Fundus photo, FOV: 45 degrees — 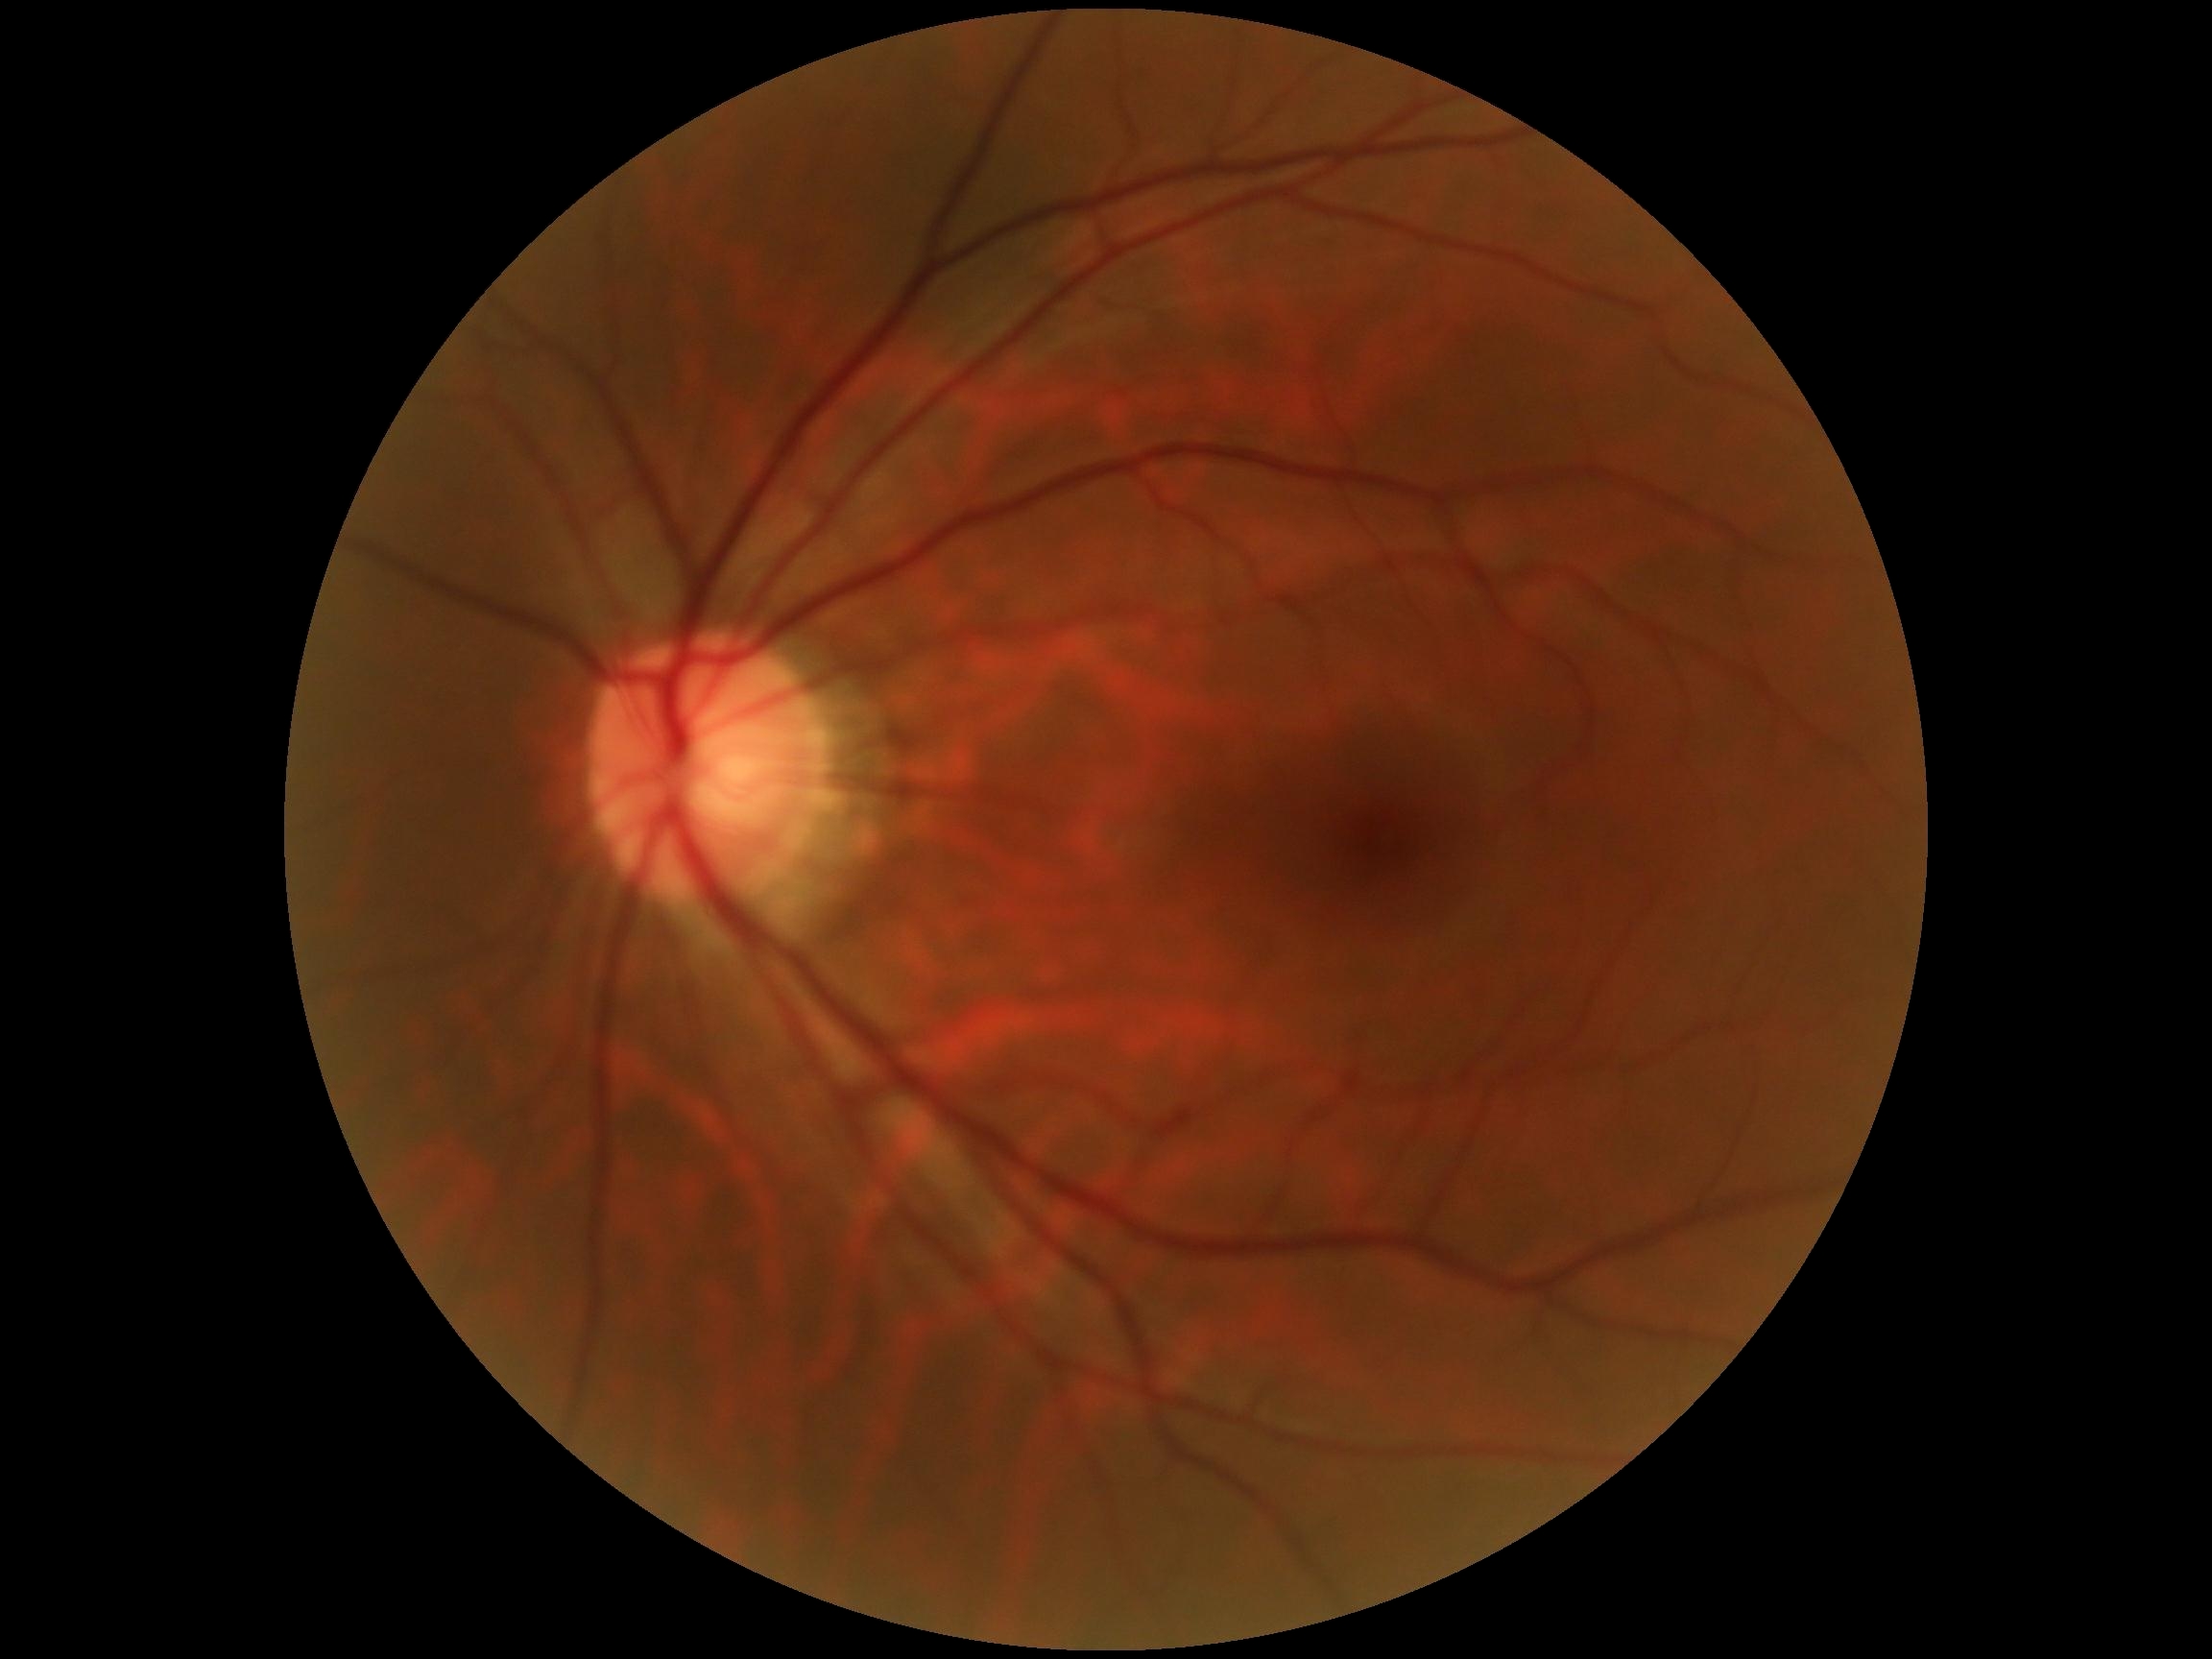
Retinopathy is grade 0 (no apparent retinopathy). No apparent diabetic retinopathy.